1515x1275px; CFP:
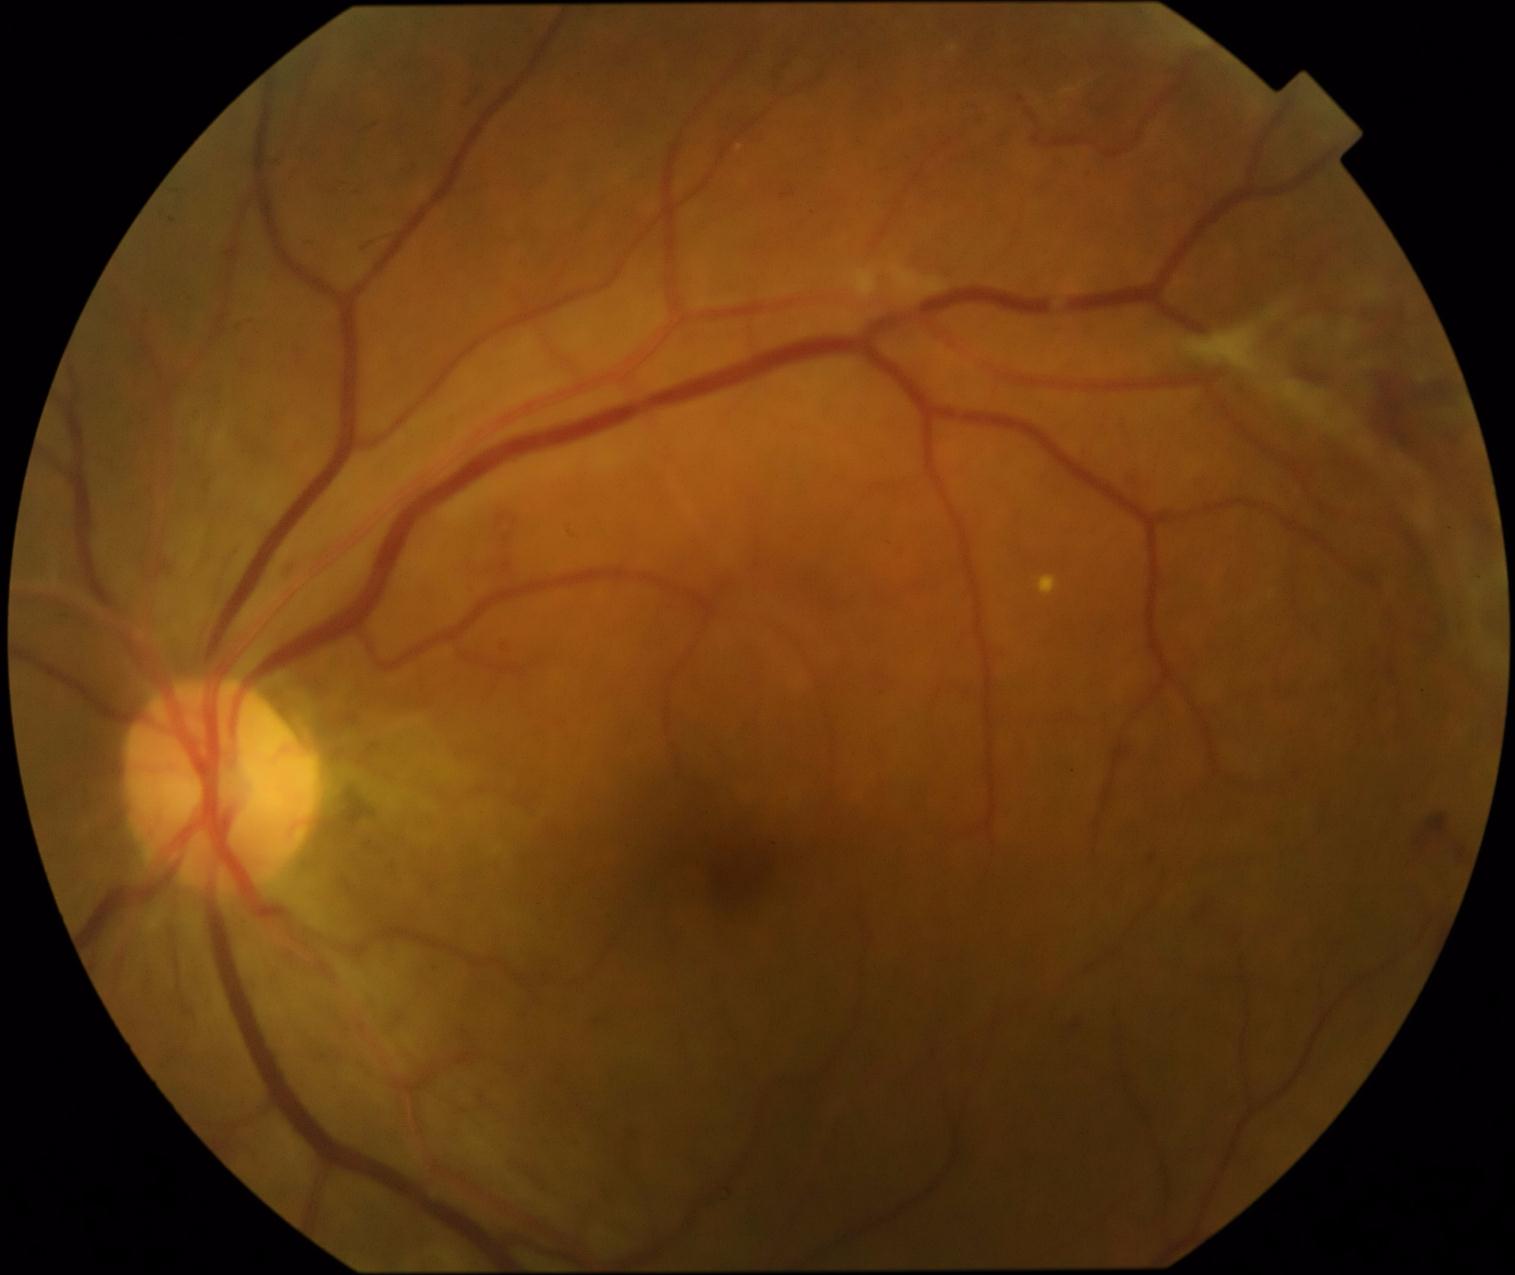

DR stage: 4/4 — neovascularization and/or vitreous/pre-retinal hemorrhage. DR class: proliferative diabetic retinopathy.